DR severity per modified Davis staging · nonmydriatic fundus photograph · 45-degree field of view · 848x848px · acquired with a NIDEK AFC-230 — 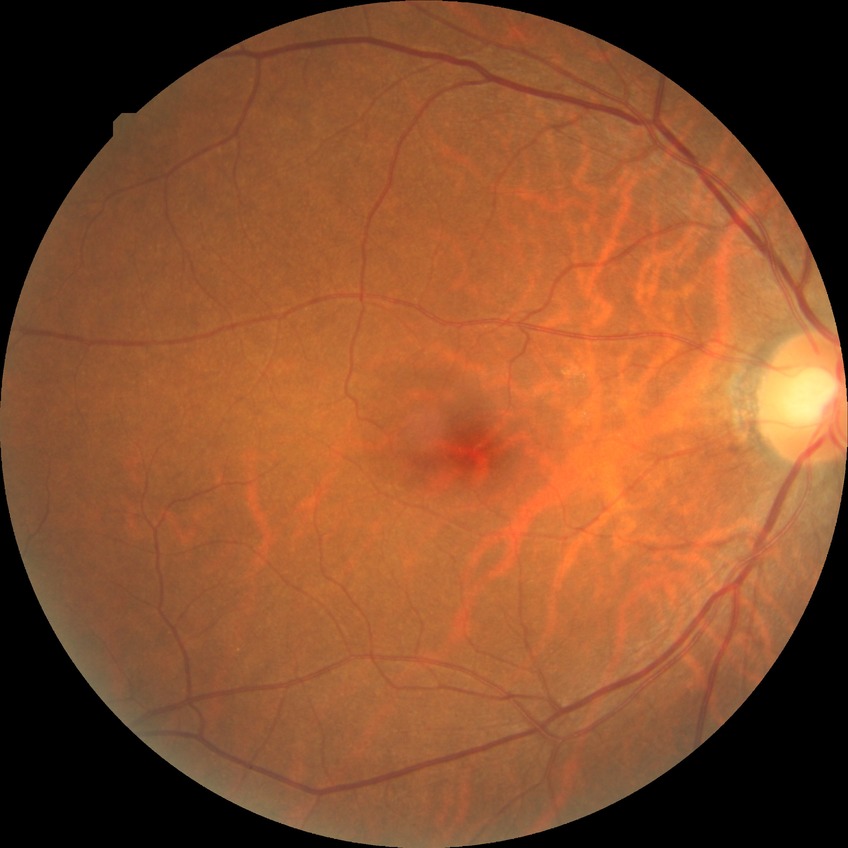 Diabetic retinopathy (DR) is no diabetic retinopathy (NDR).